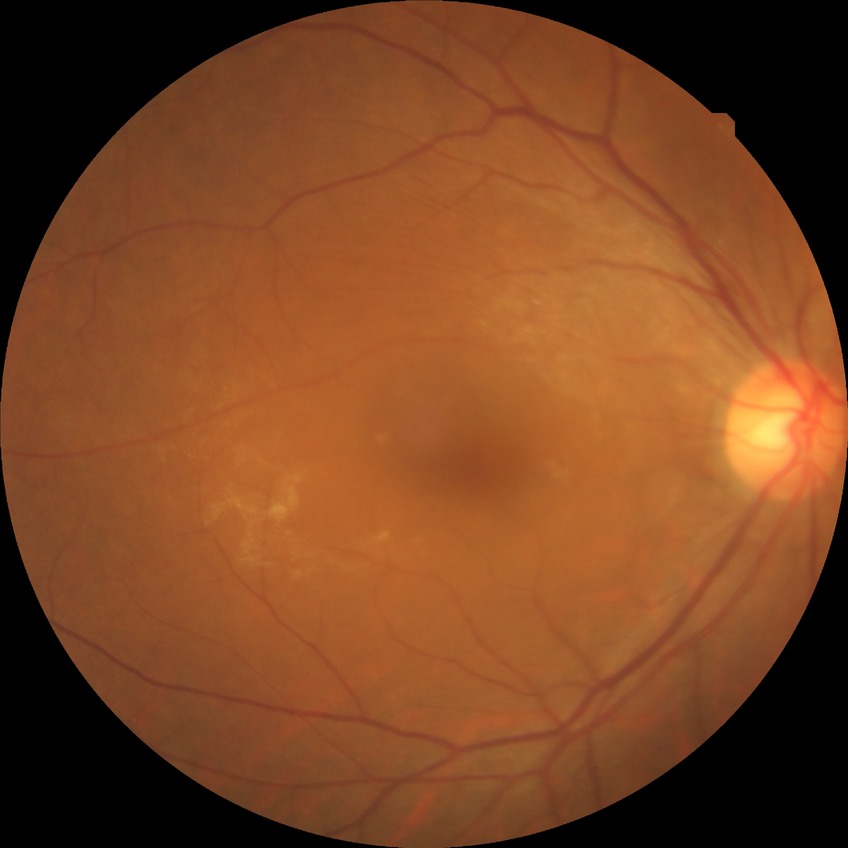 Assessment:
• diabetic retinopathy grade — no diabetic retinopathy